Pediatric retinal photograph (wide-field) · camera: Phoenix ICON (100° FOV) · 1240x1240:
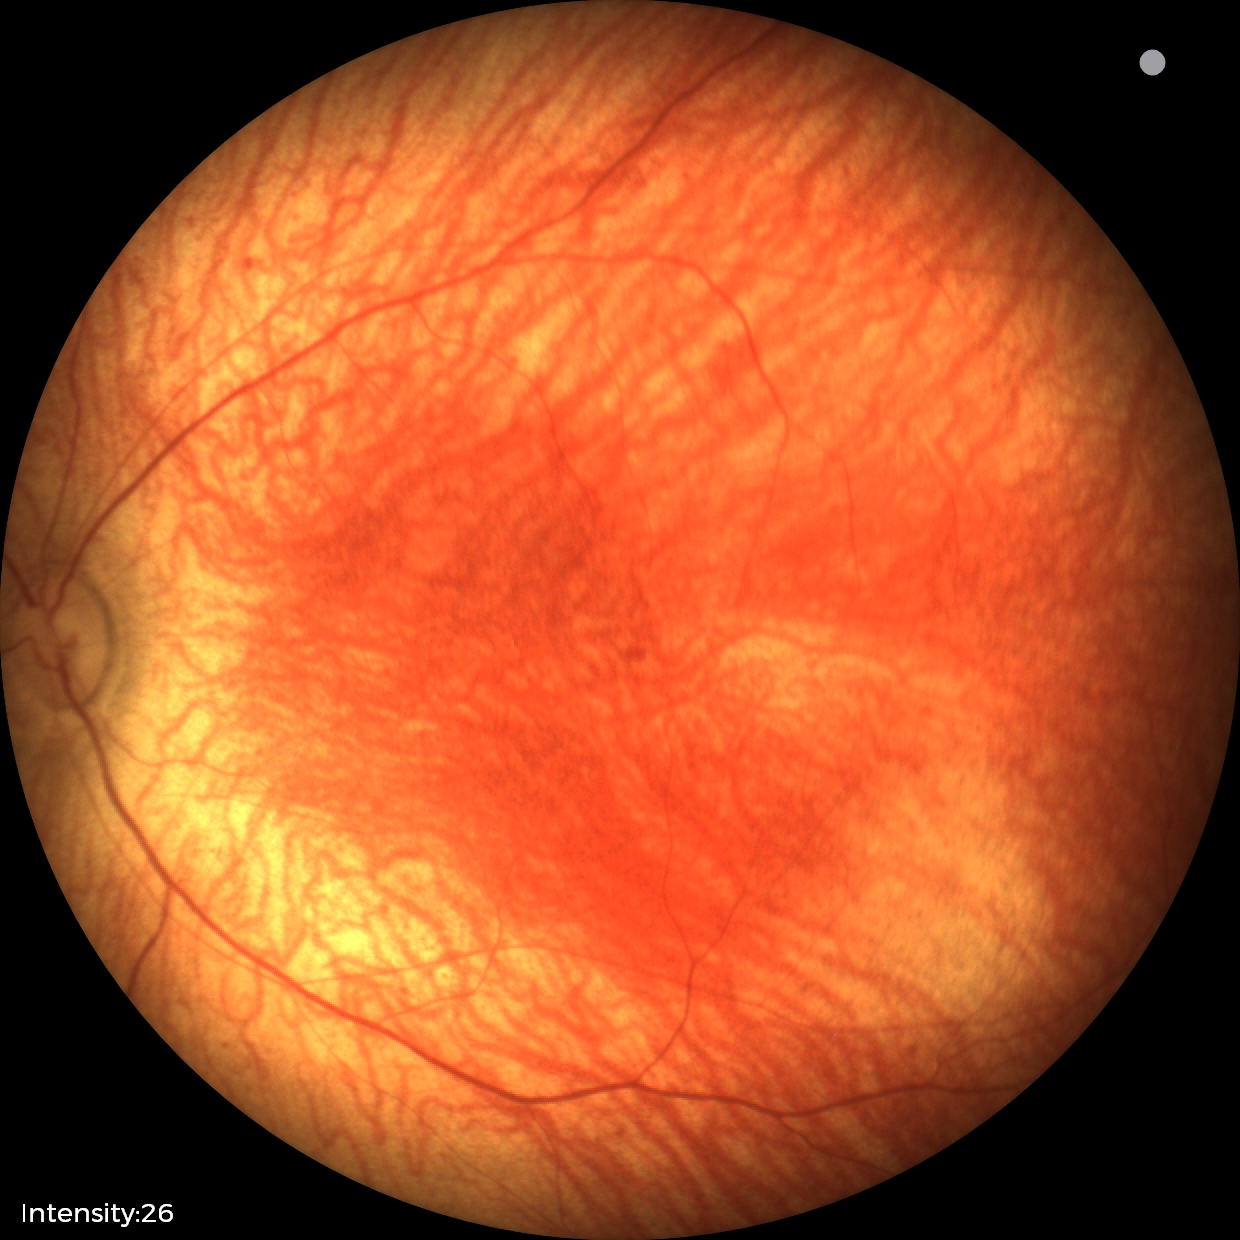 Normal screening examination.